Color fundus image — 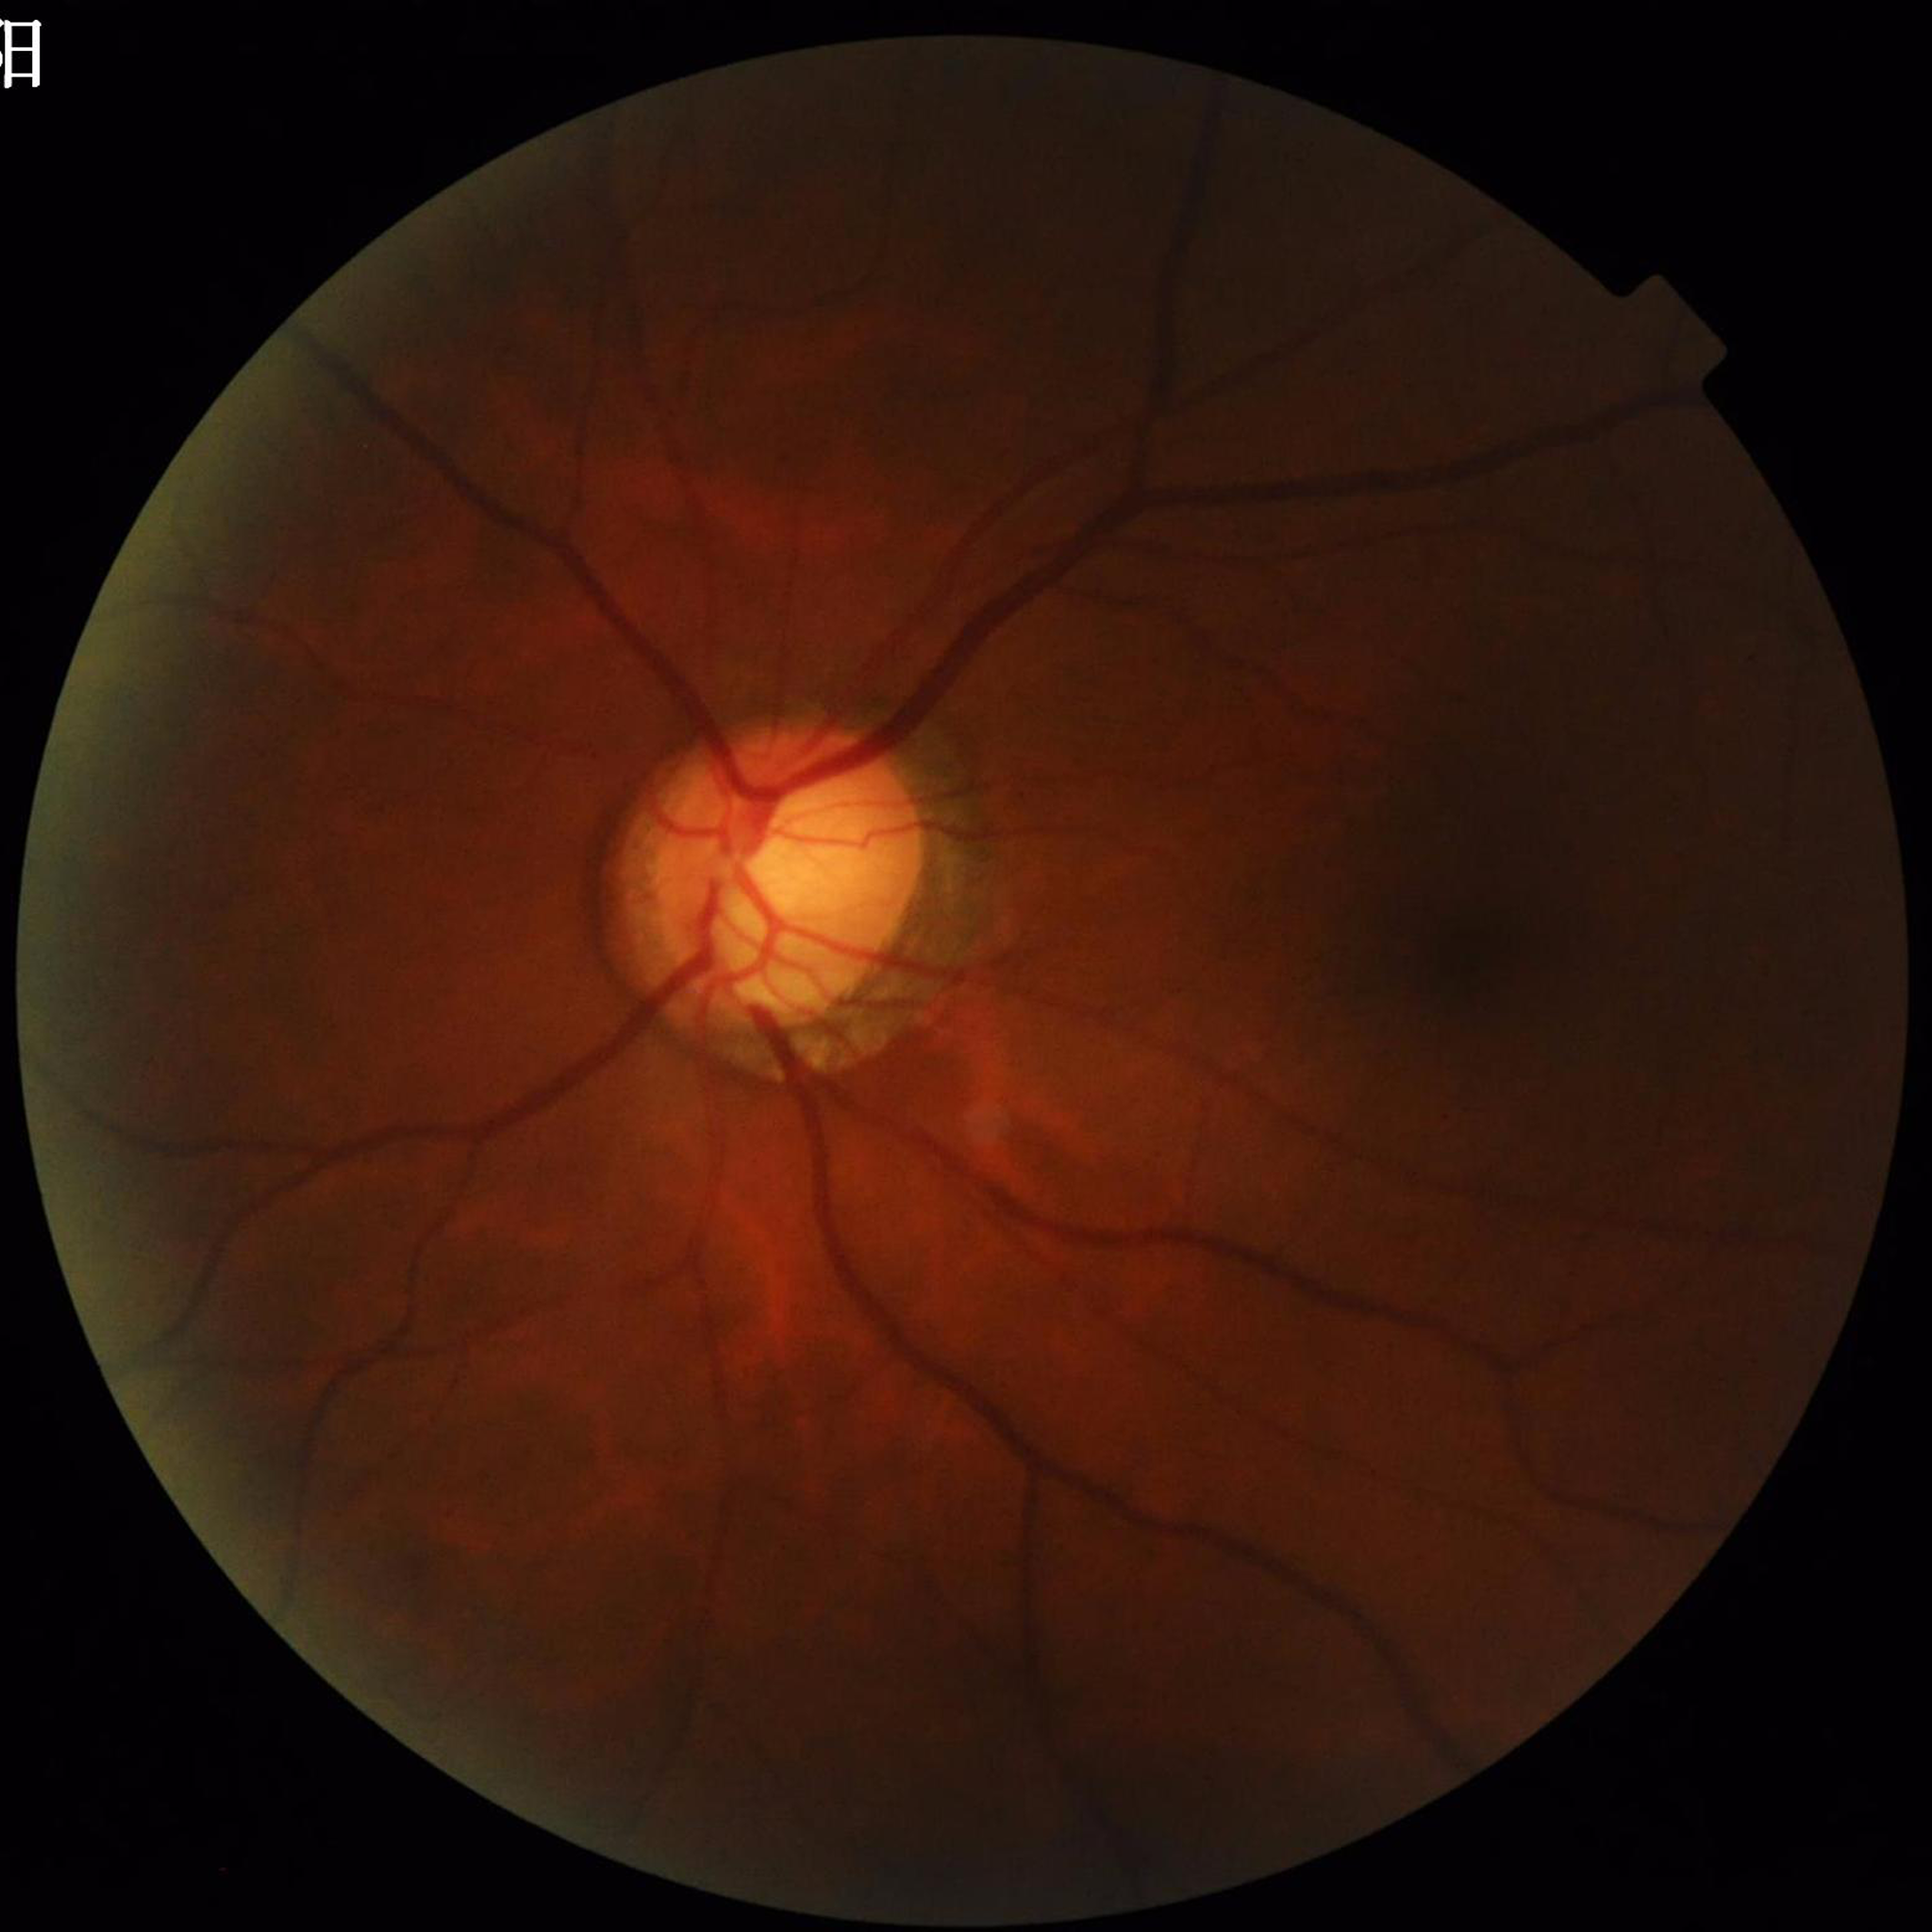 Automated quality assessment: suboptimal — illumination/color distortion. Patient diagnosed with glaucoma.